Fundus photo. Camera: Remidio FOP fundus camera. 1659 x 2212 pixels — 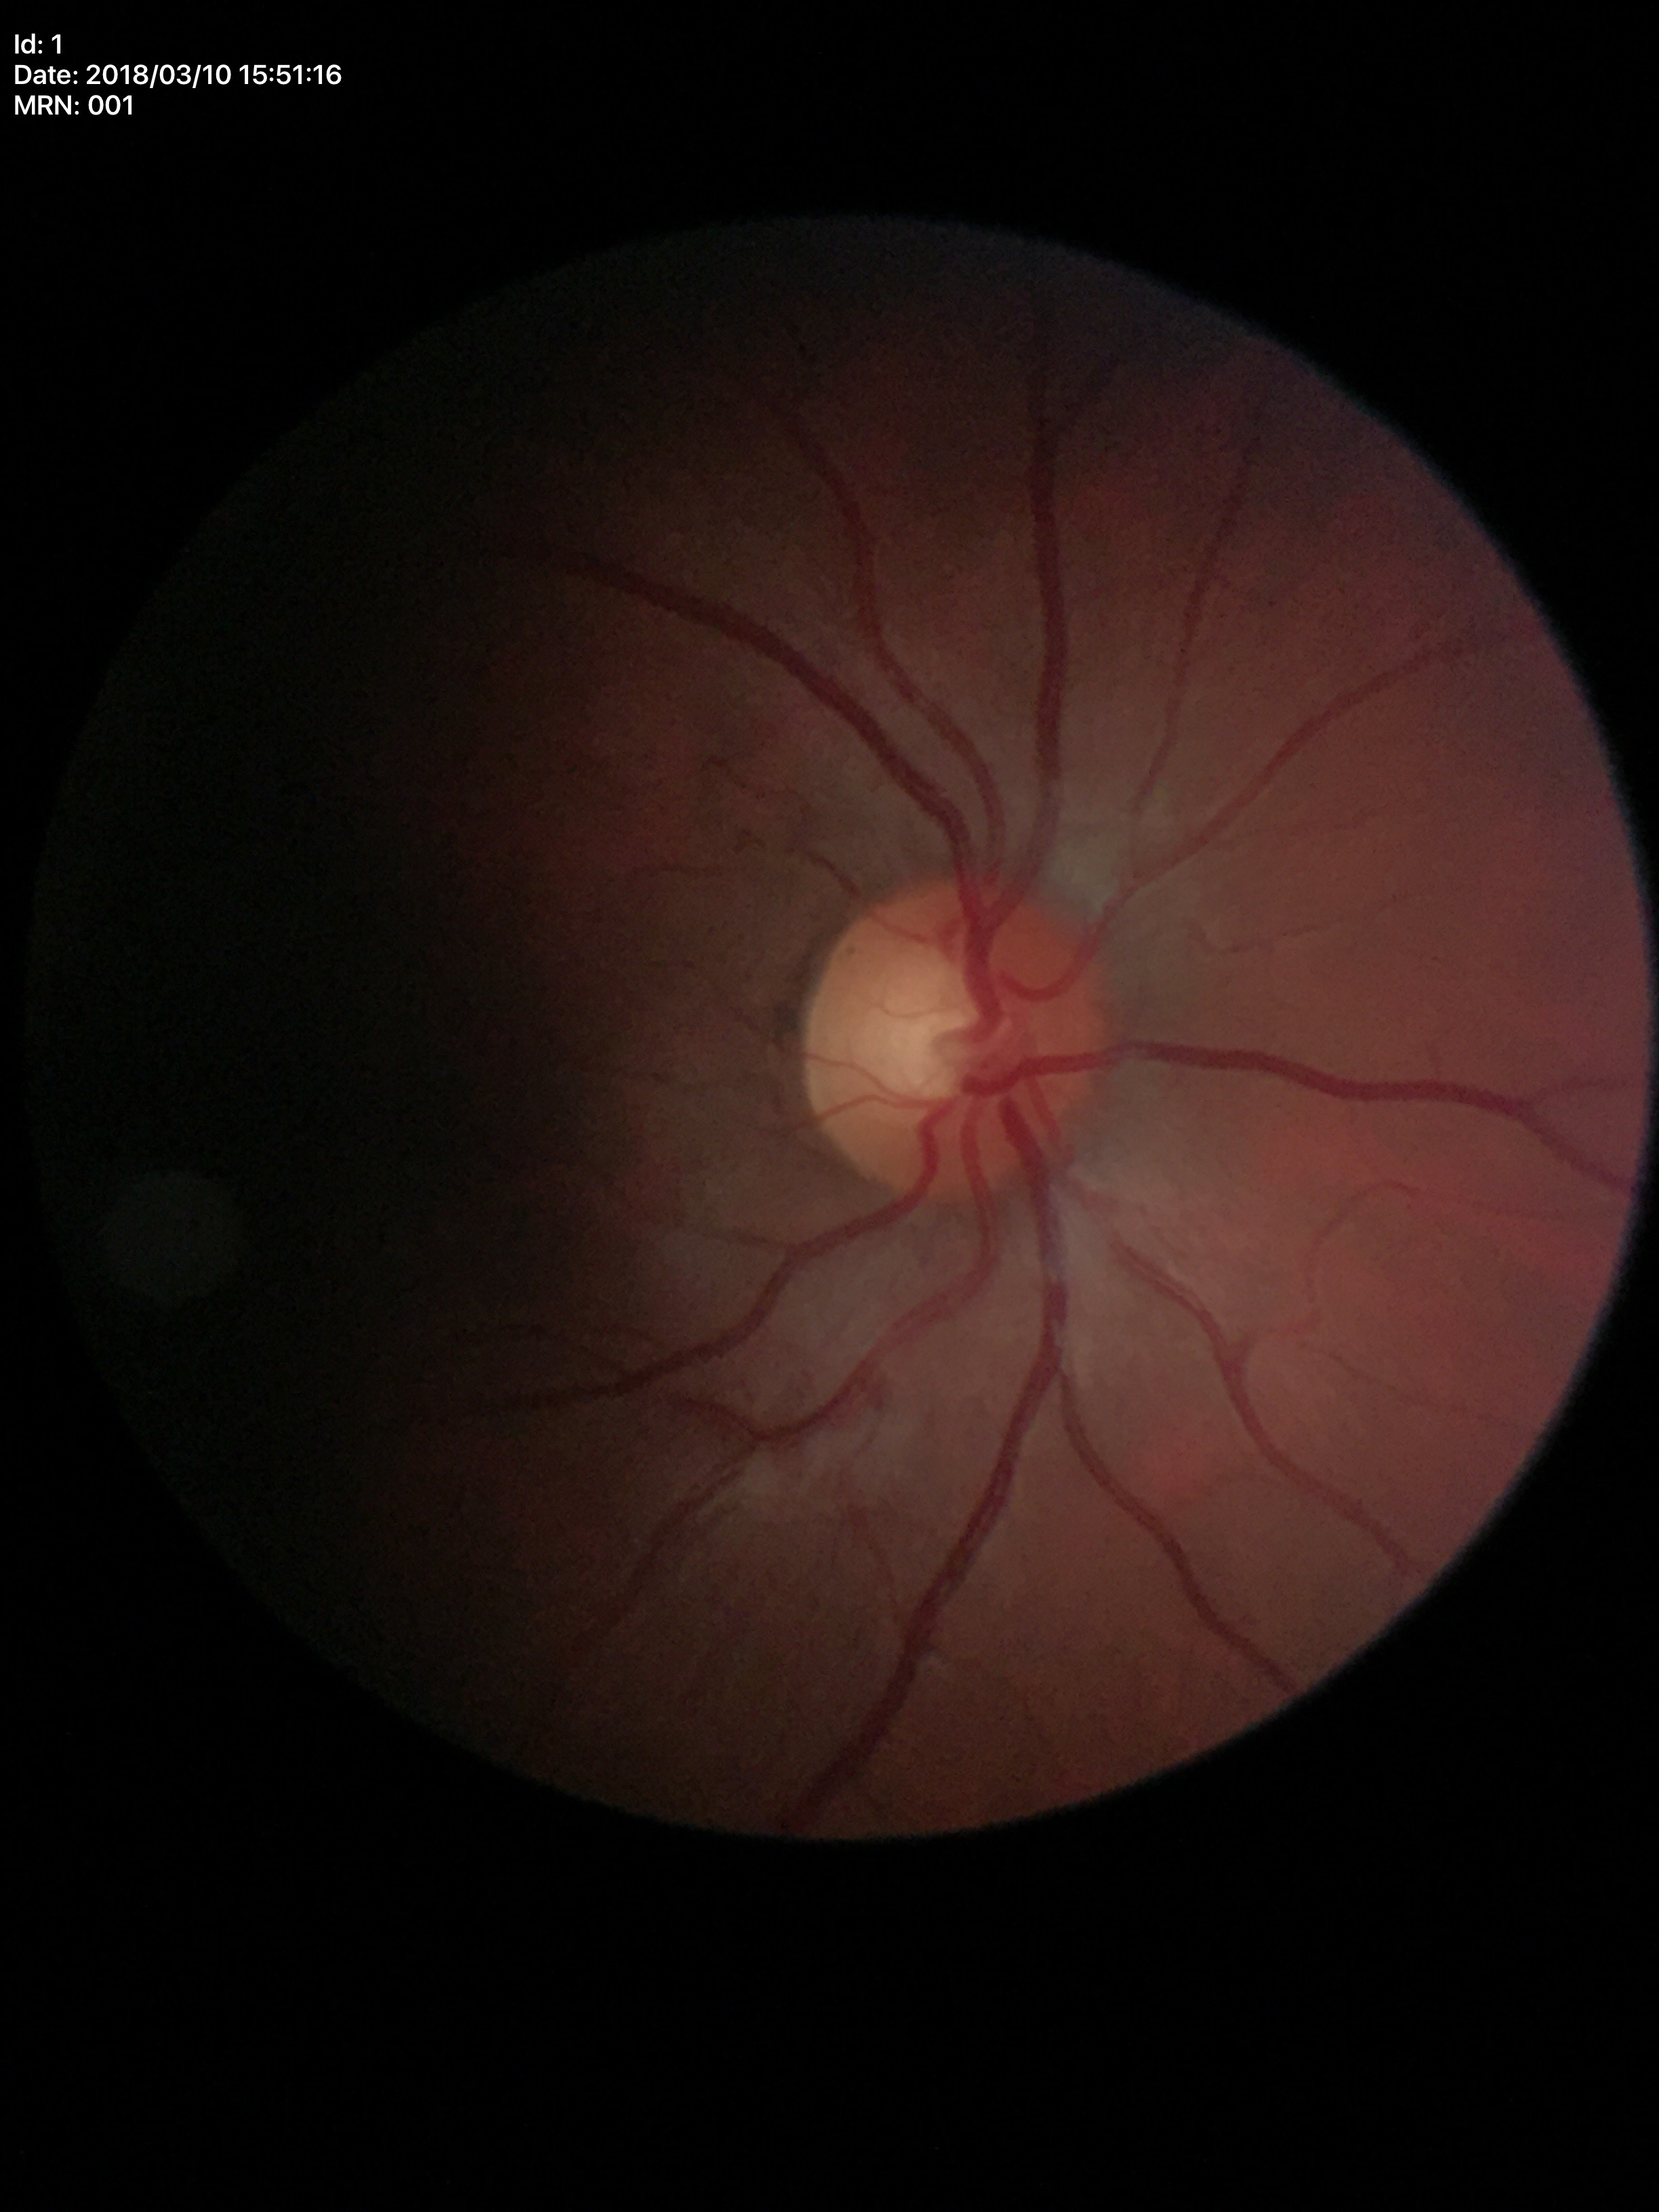 Glaucoma impression: negative; vertical C/D ratio (VCDR): 0.52; horizontal C/D ratio (HCDR): 0.51